Infant wide-field fundus photograph
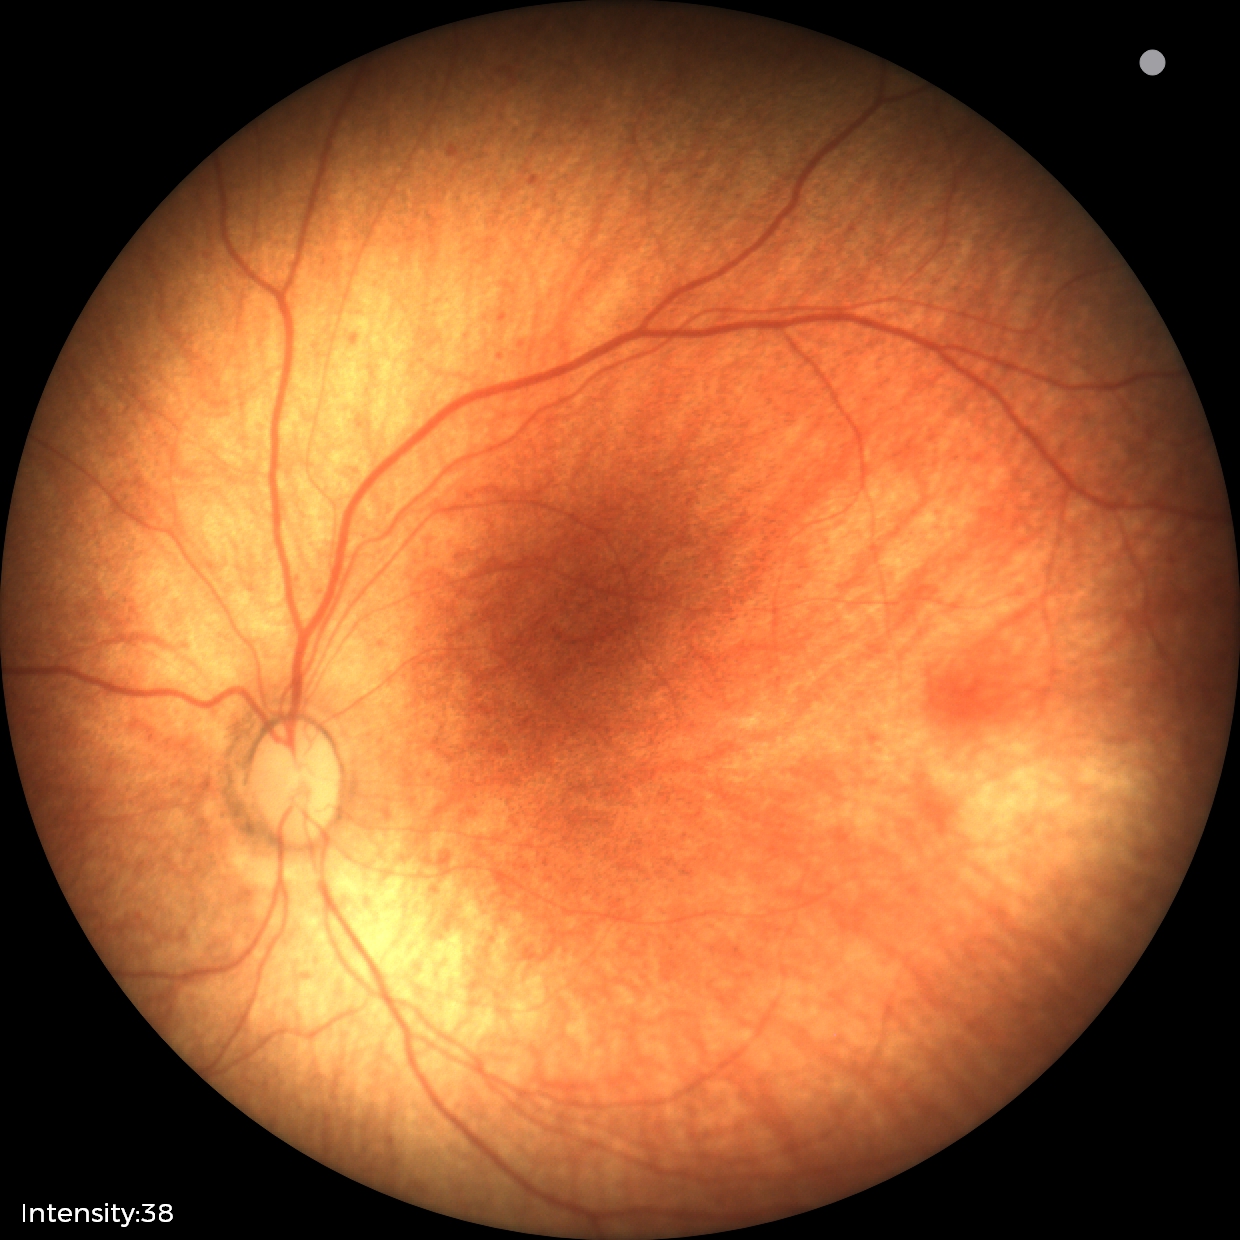

Screening examination with no abnormal retinal findings.